Posterior pole photograph, NIDEK AFC-230 fundus camera, nonmydriatic — 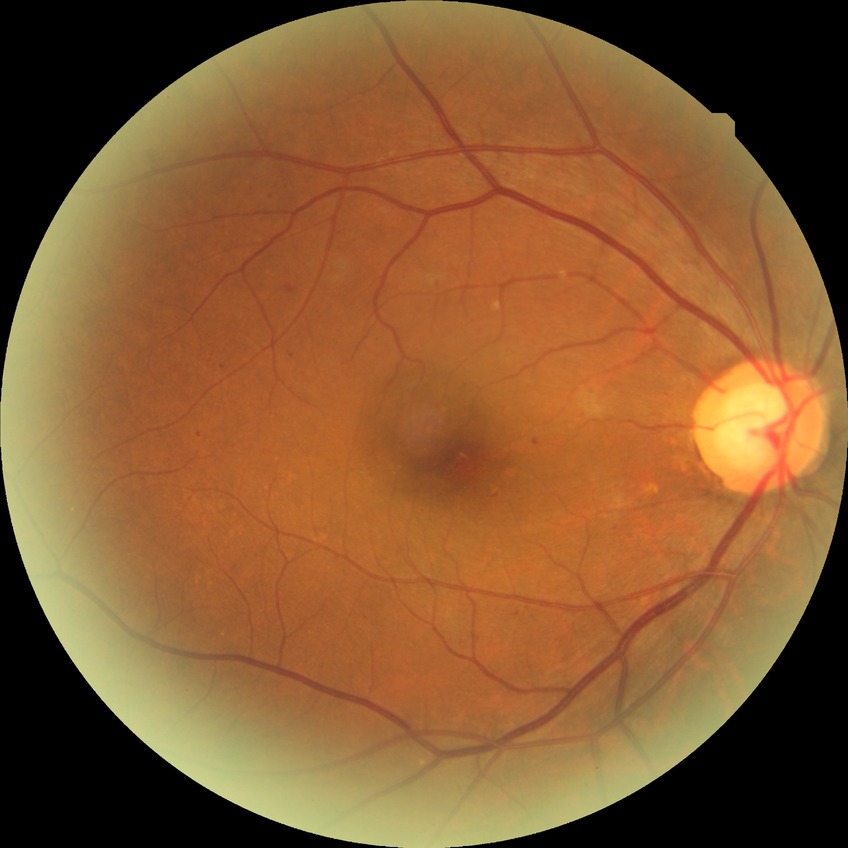 Diabetic retinopathy (DR): SDR (simple diabetic retinopathy).
Disease class: non-proliferative diabetic retinopathy.